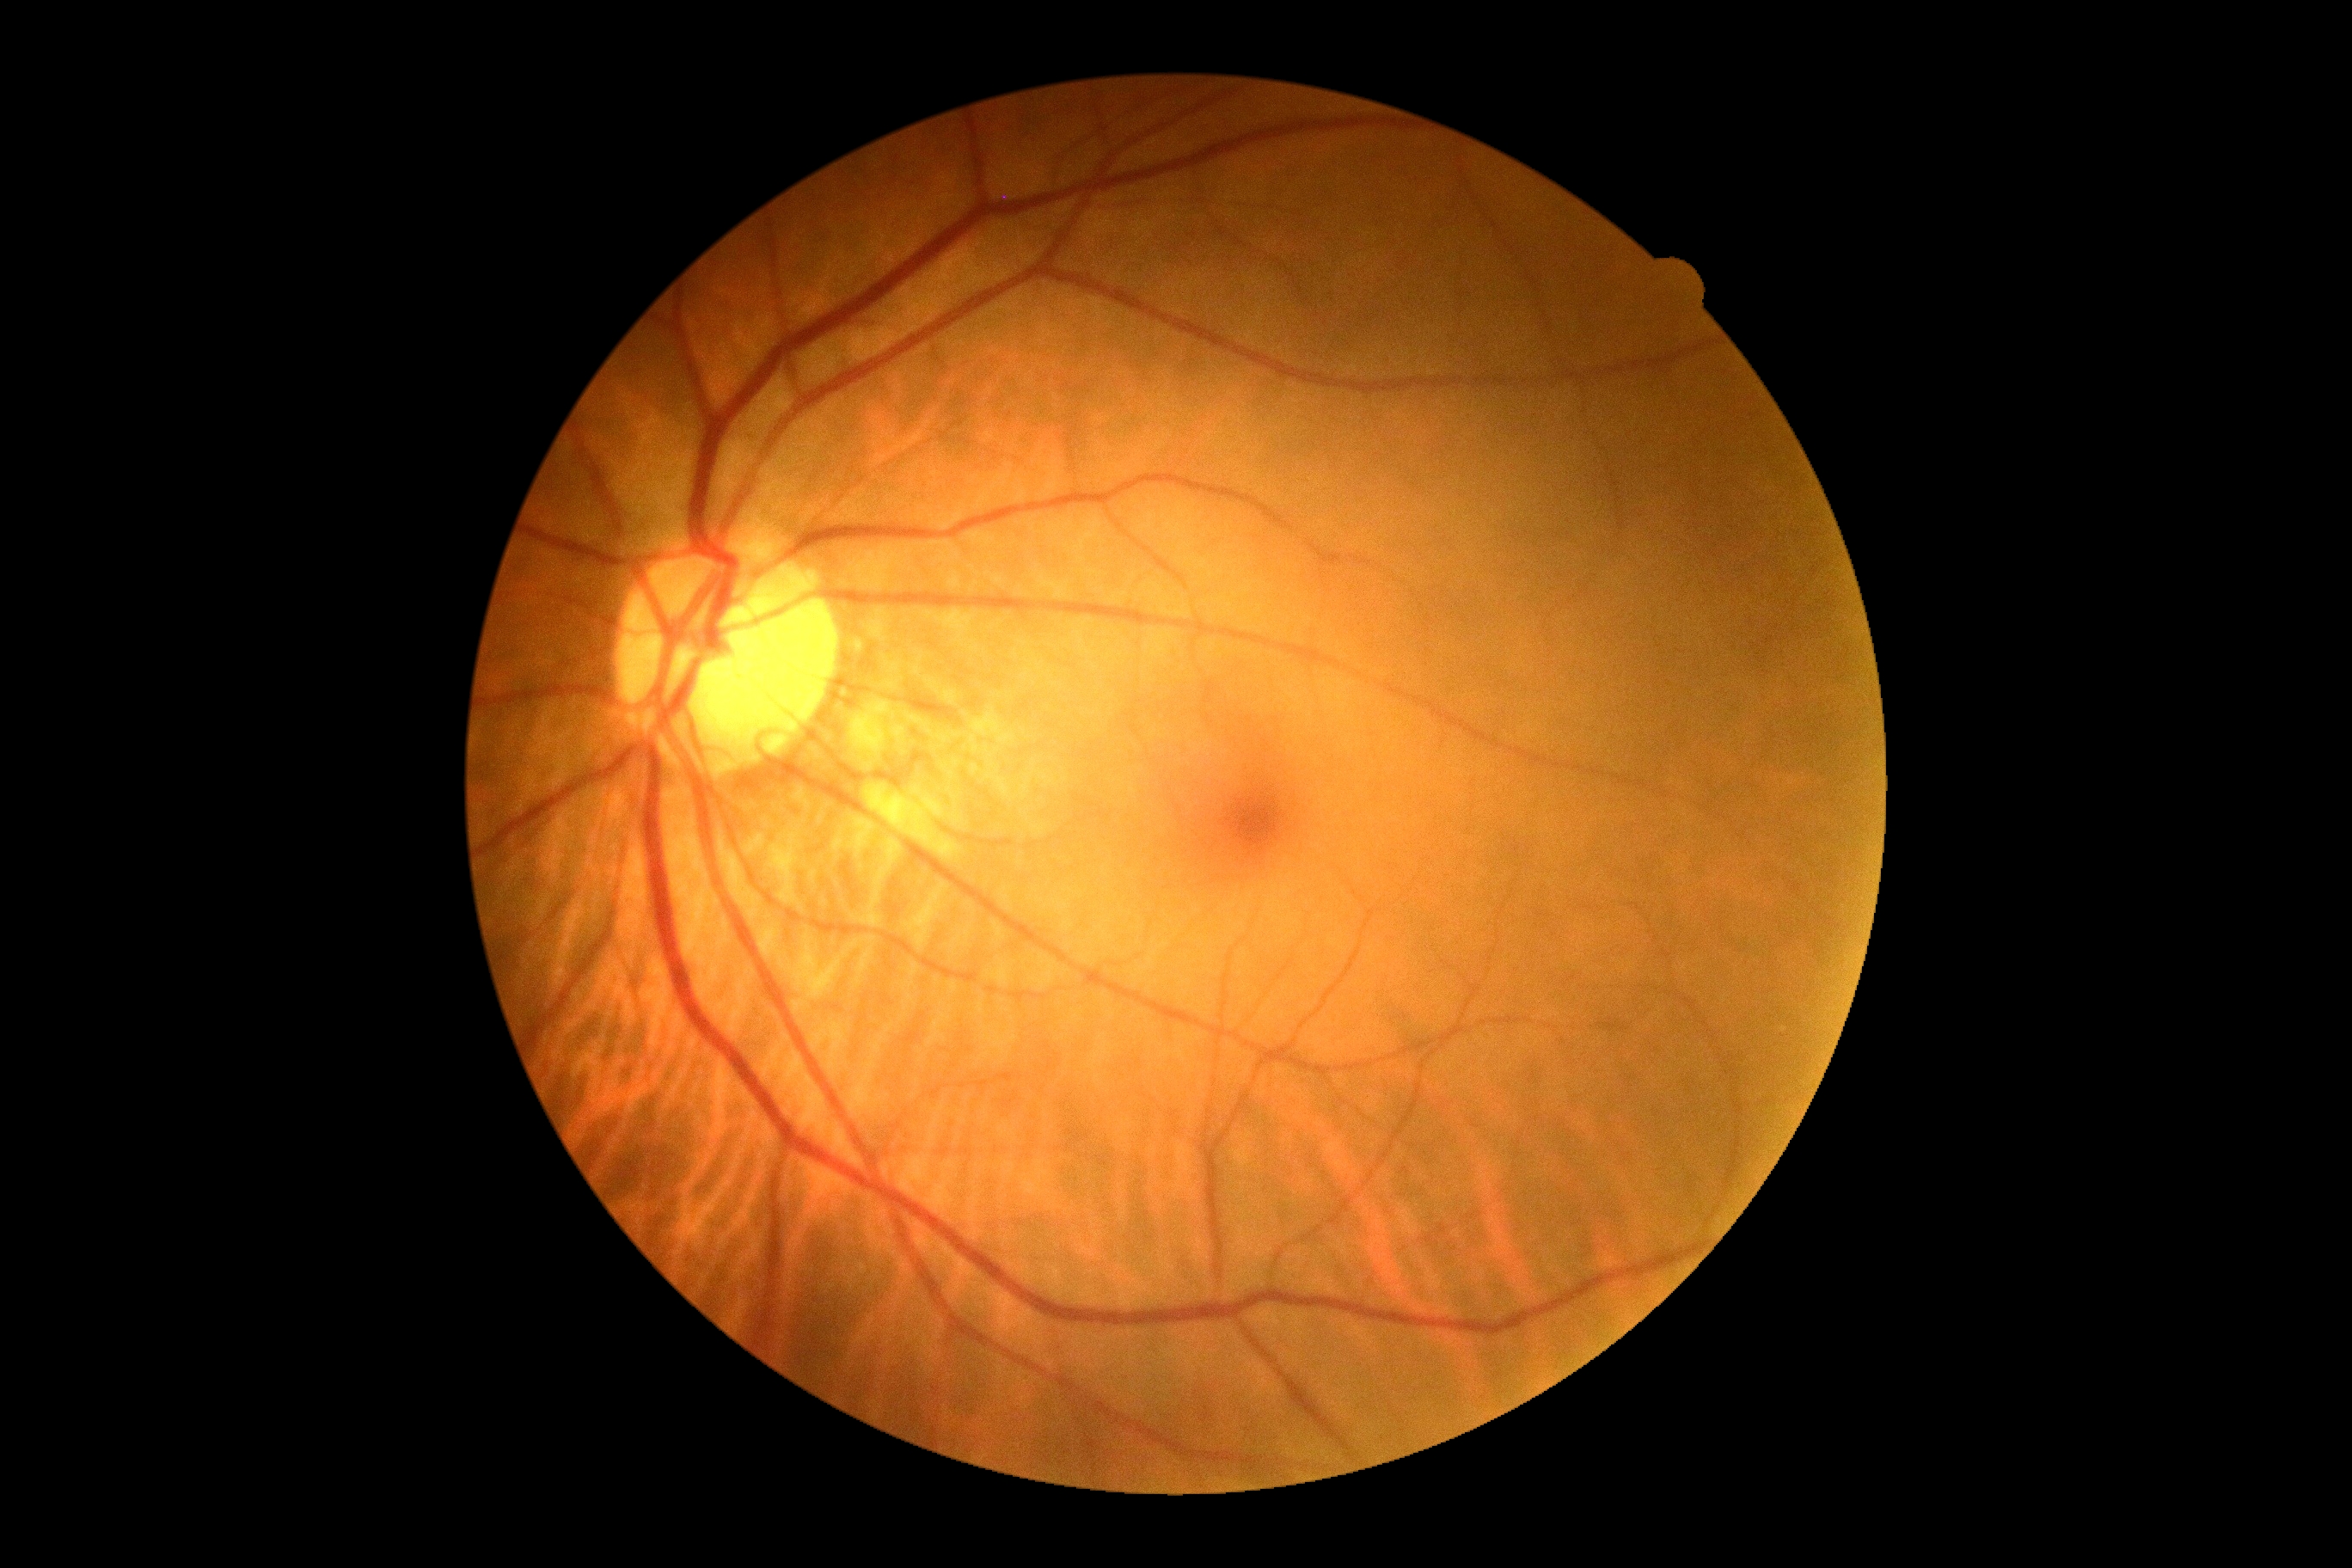 {"dr_grade": "grade 0 (no apparent retinopathy)"}